Wide-field contact fundus photograph of an infant
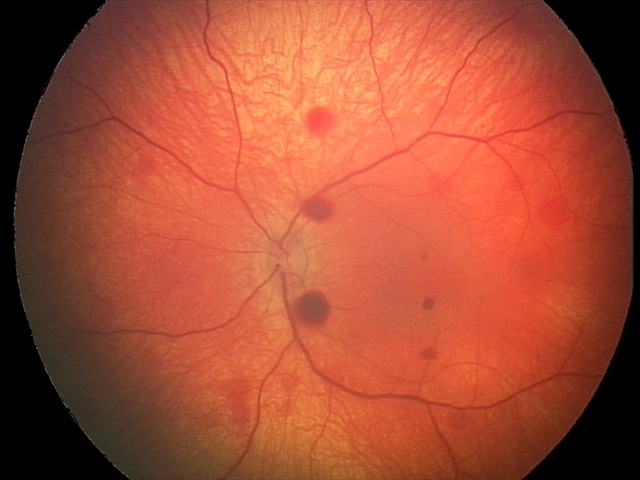
Diagnosis from this screening exam: retinal hemorrhages.